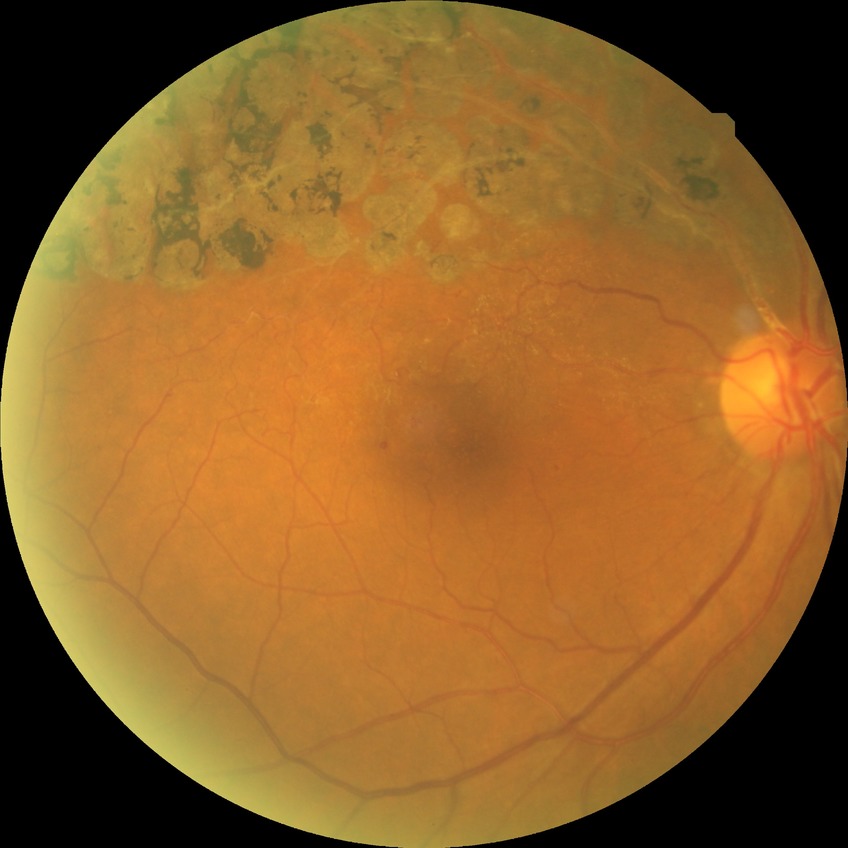

diabetic retinopathy (DR) = NDR (no diabetic retinopathy)